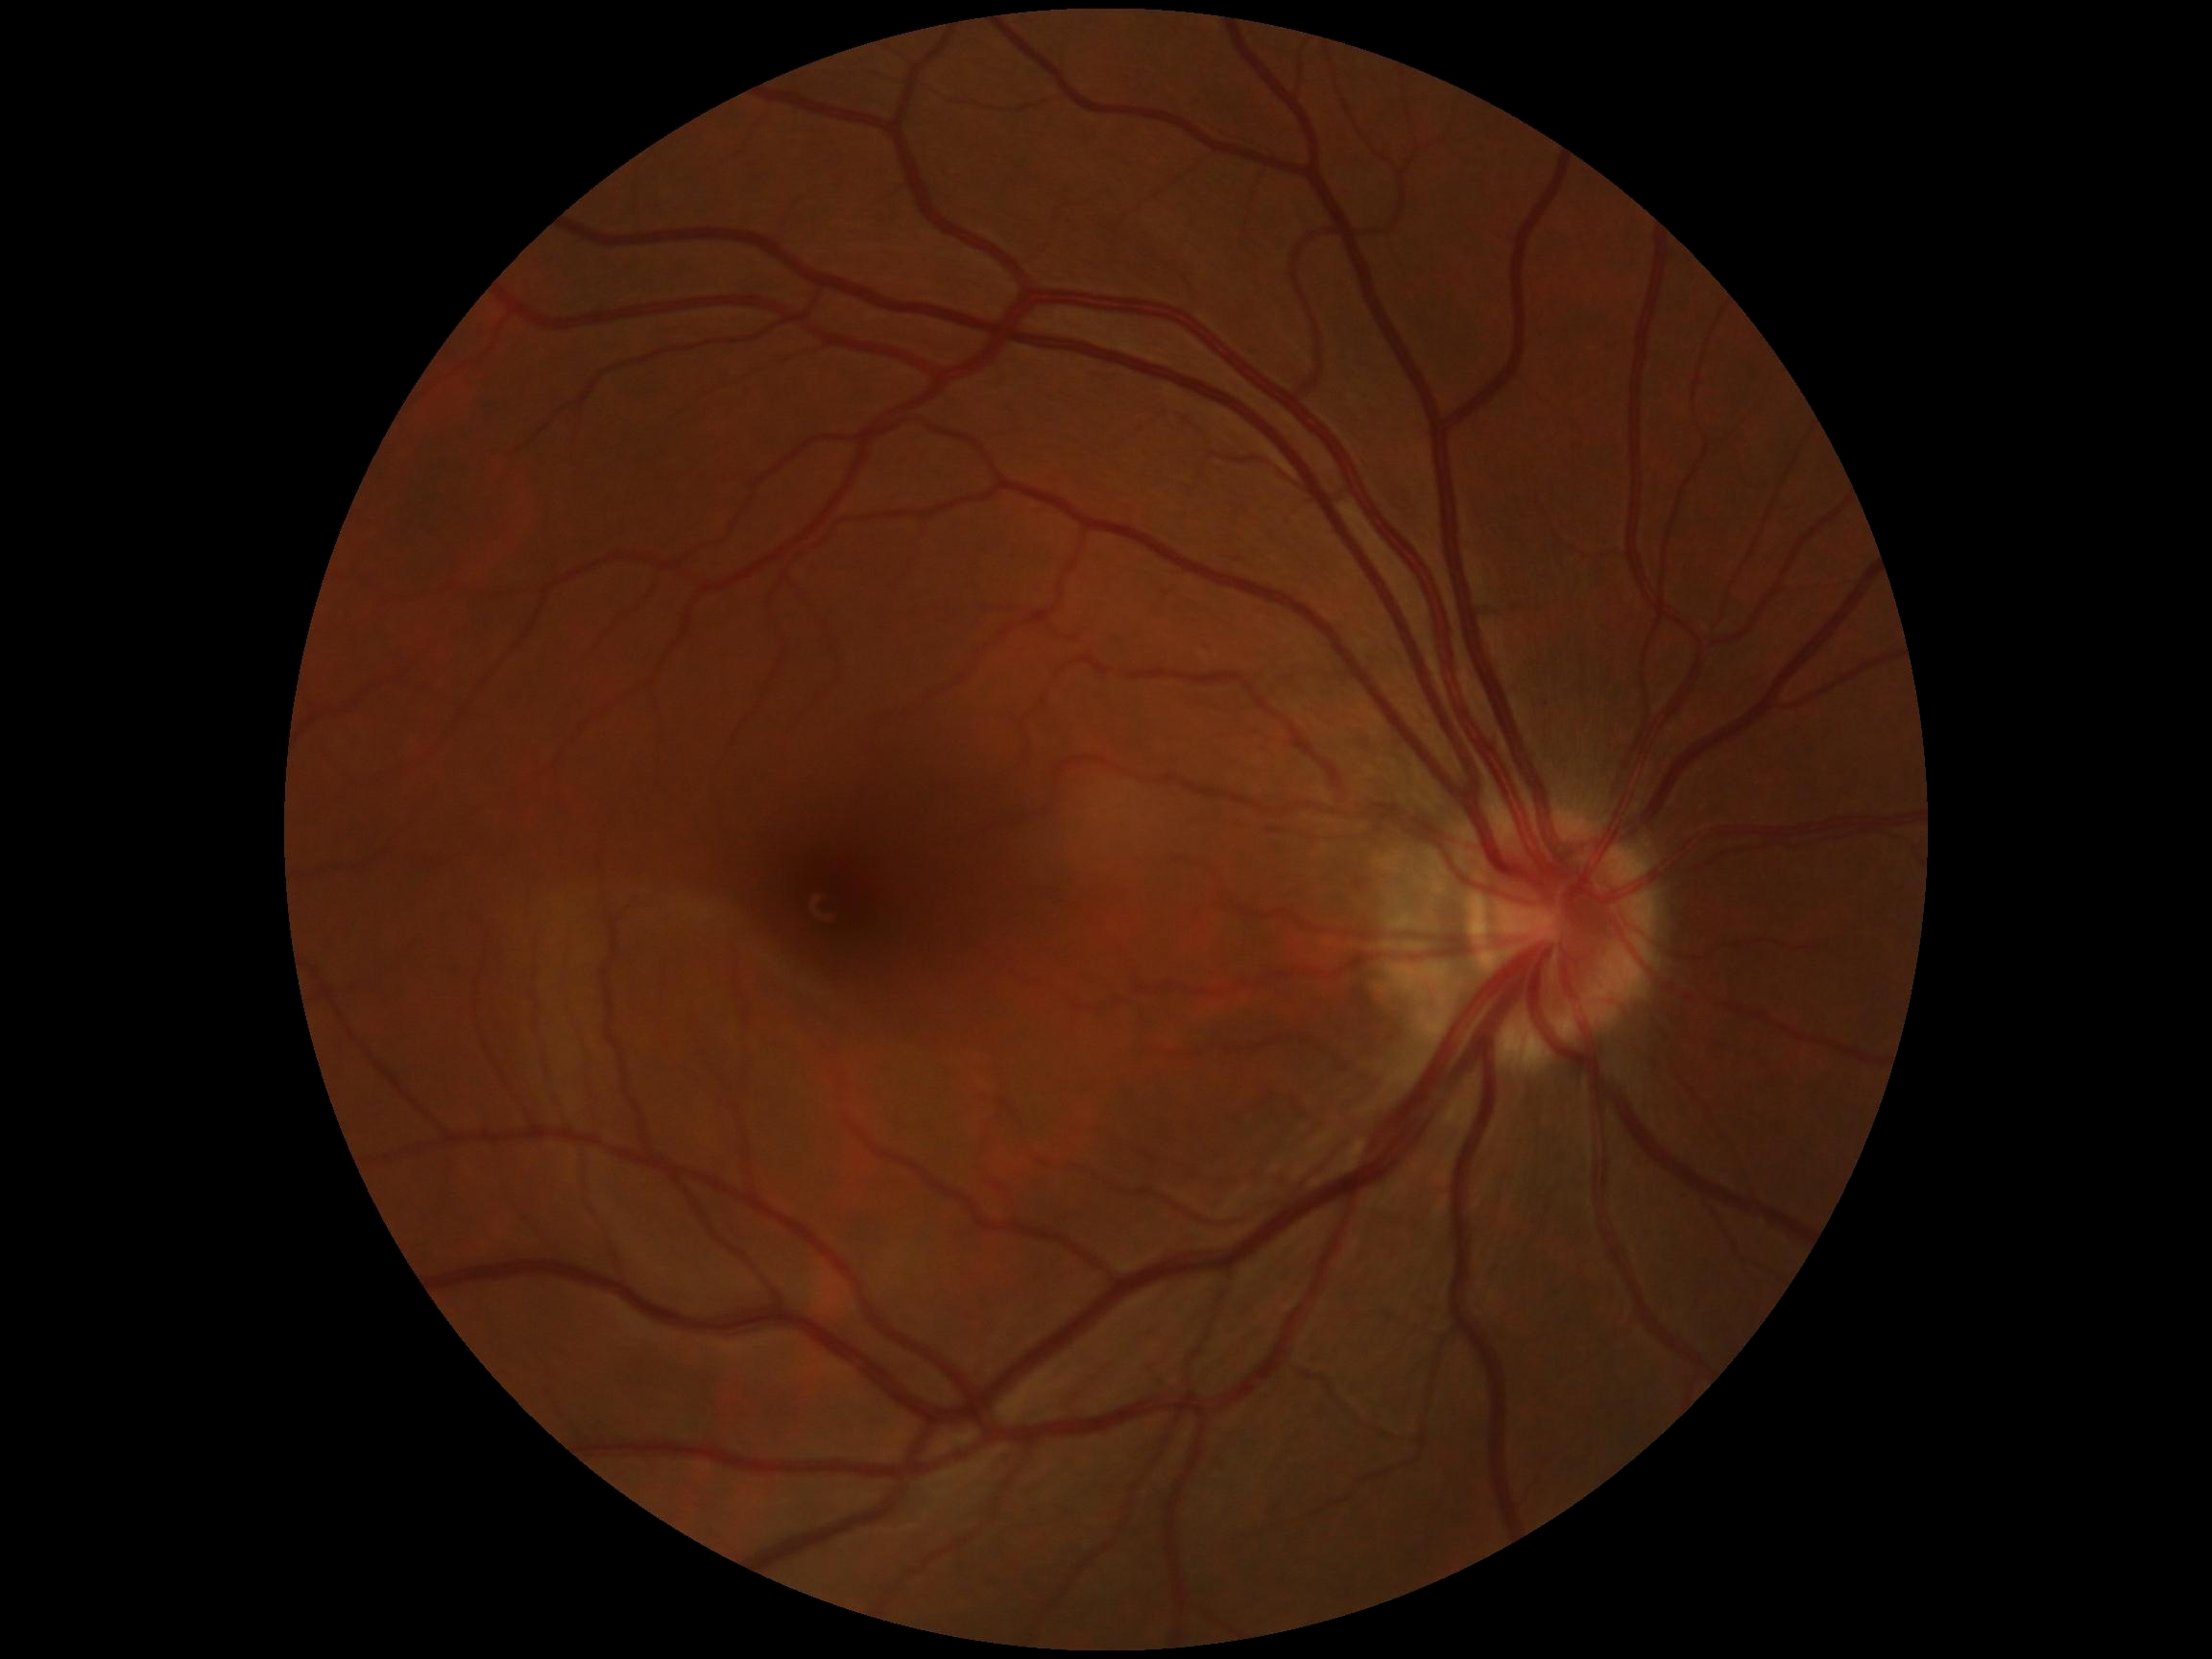 retinopathy: grade 0 (no apparent retinopathy).